Davis DR grading; without pupil dilation; posterior pole color fundus photograph — 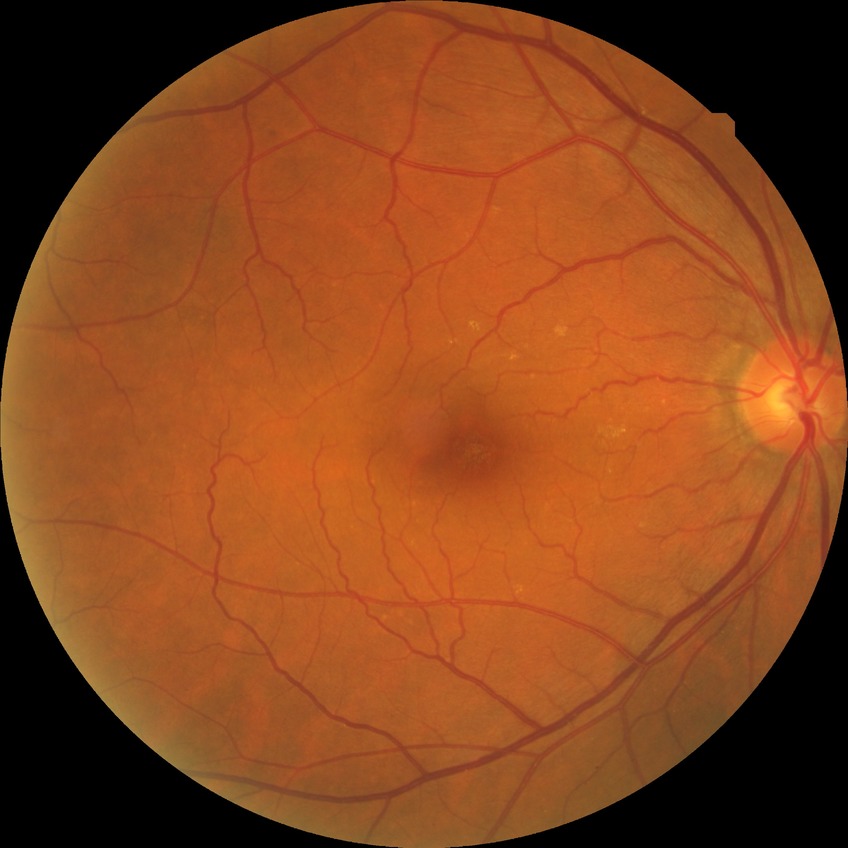

Assessment:
– diabetic retinopathy (DR): no diabetic retinopathy (NDR)